Color fundus photograph · 1659 x 2212 pixels · camera: Remidio Fundus on Phone (FOP) camera: 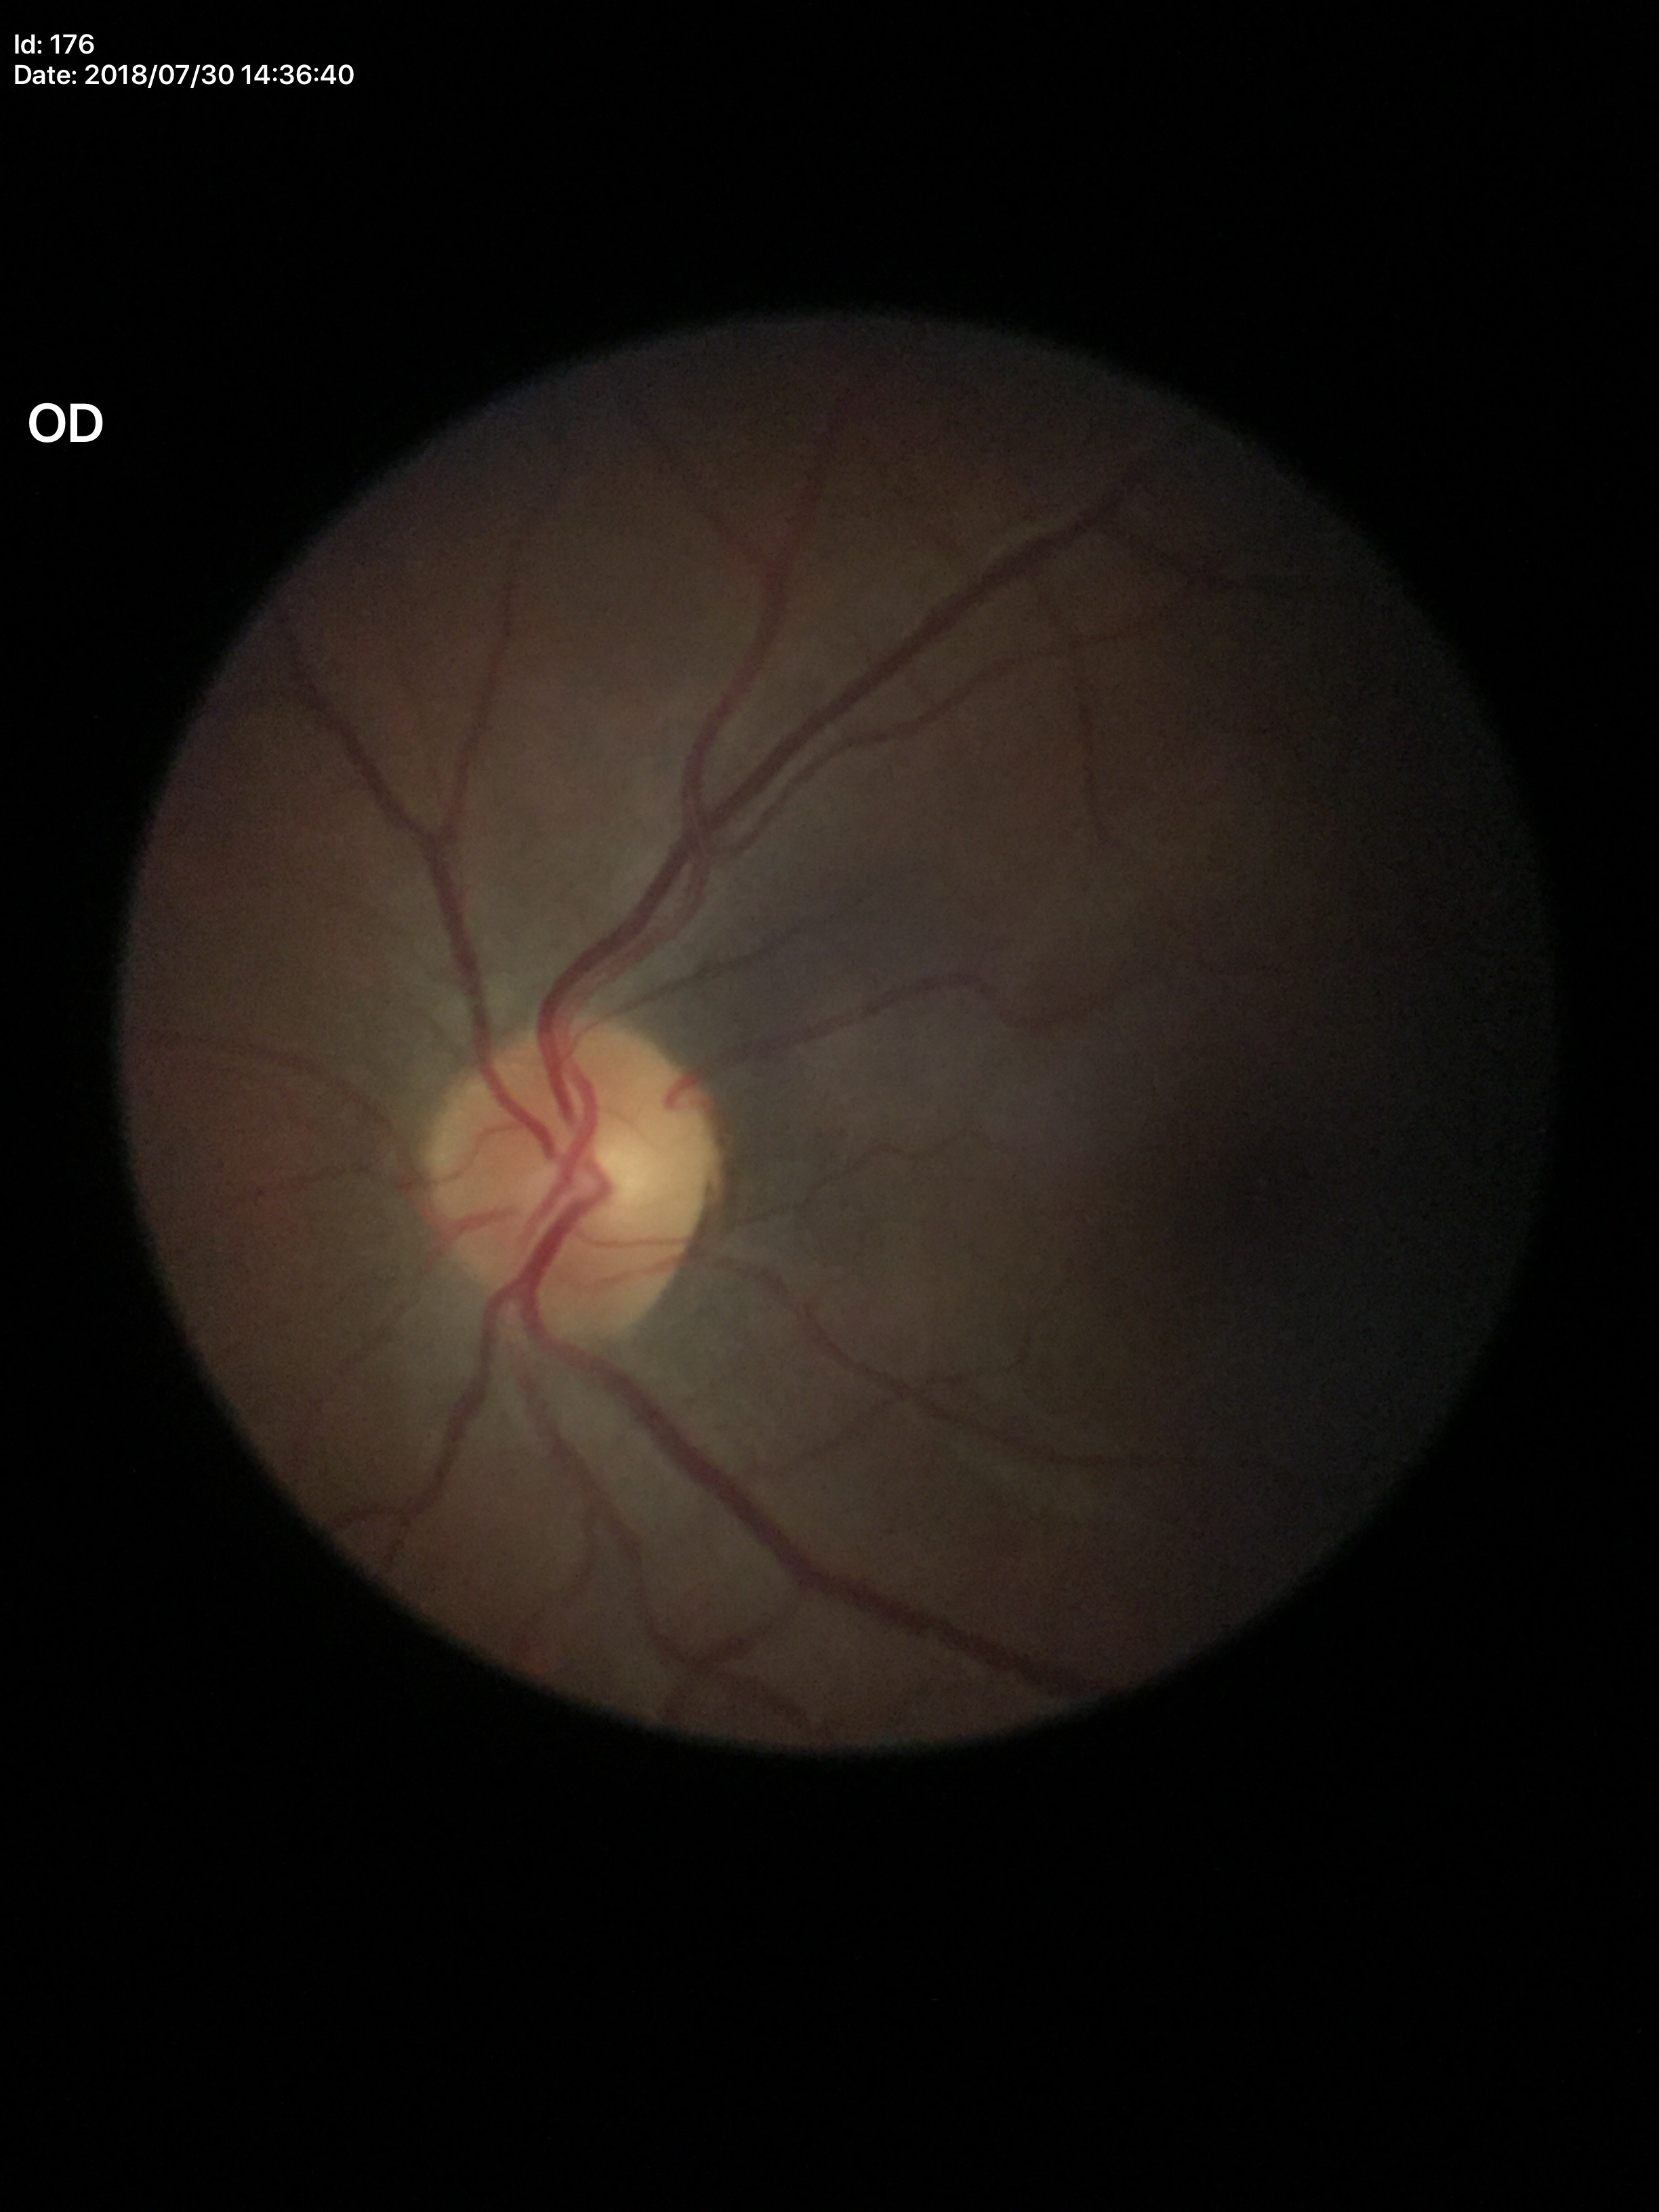

Glaucoma decision: no suspicious findings. Vertical CDR is 0.48.